1659x2212px, captured on a Remidio smartphone fundus camera: 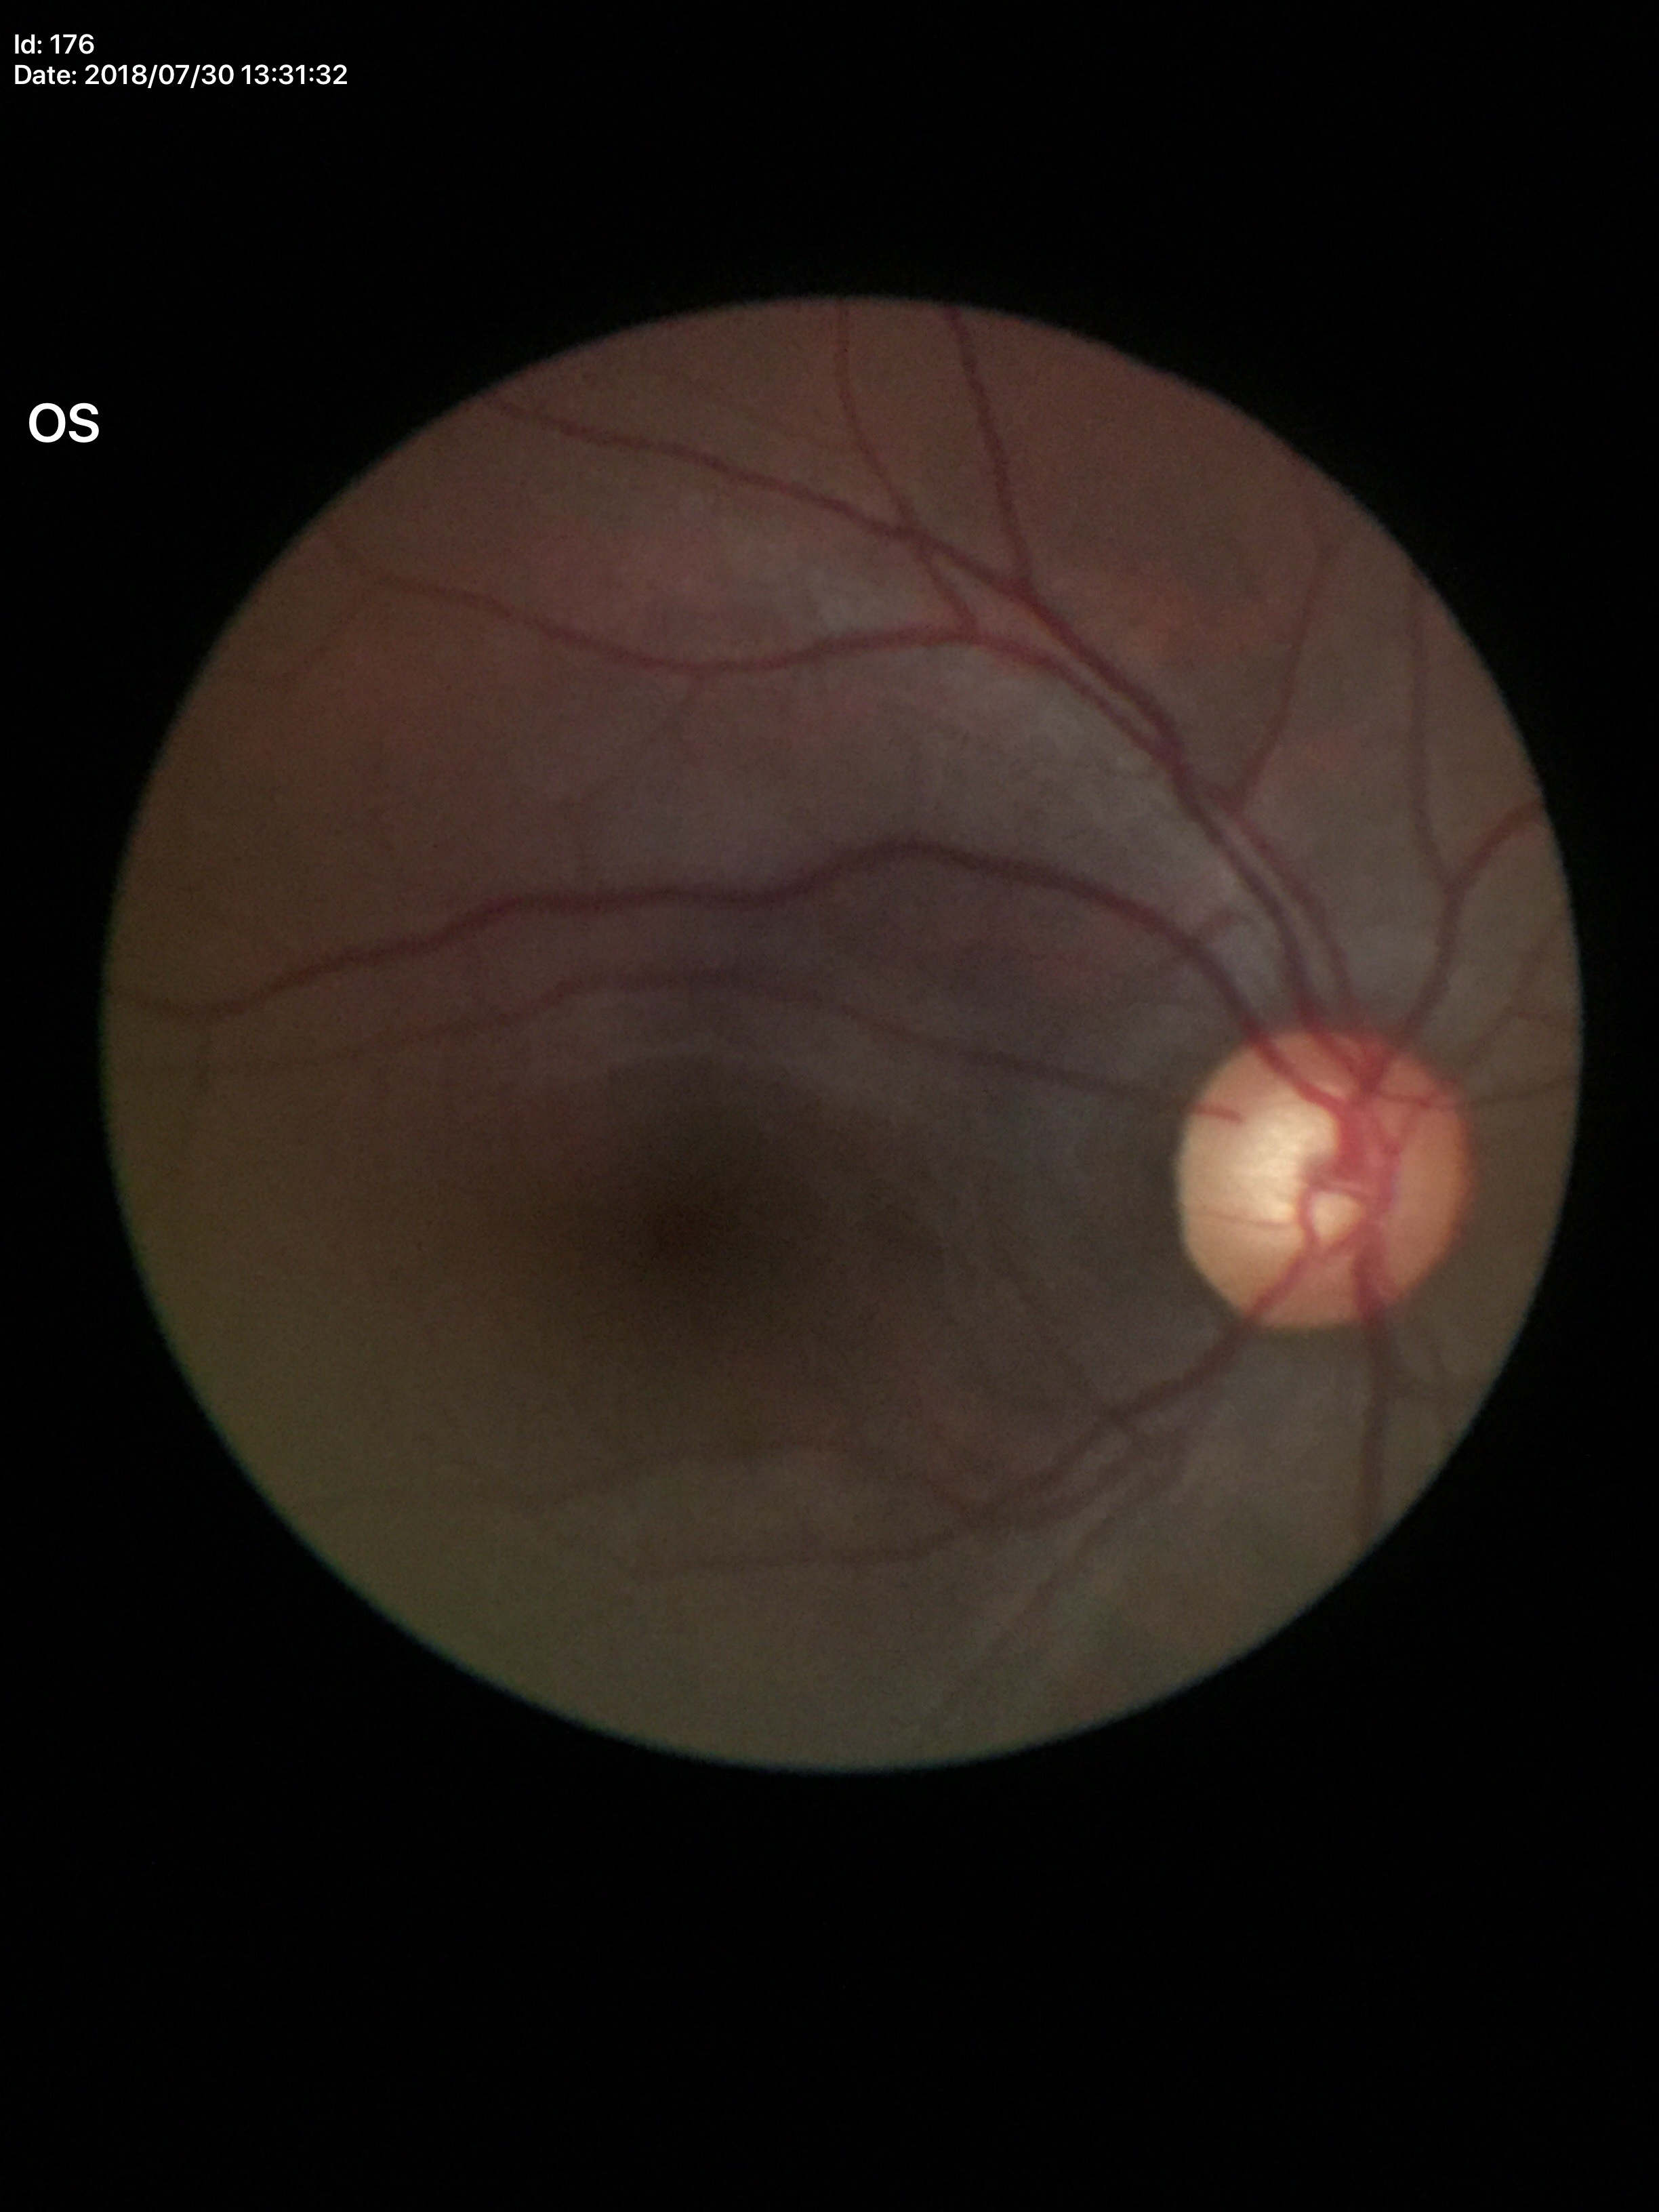 Glaucoma screening impression = suspicious findings; VCDR = 0.63; HCDR = 0.61.